Wide-field contact fundus photograph of an infant · Phoenix ICON, 100° FOV · 1240x1240
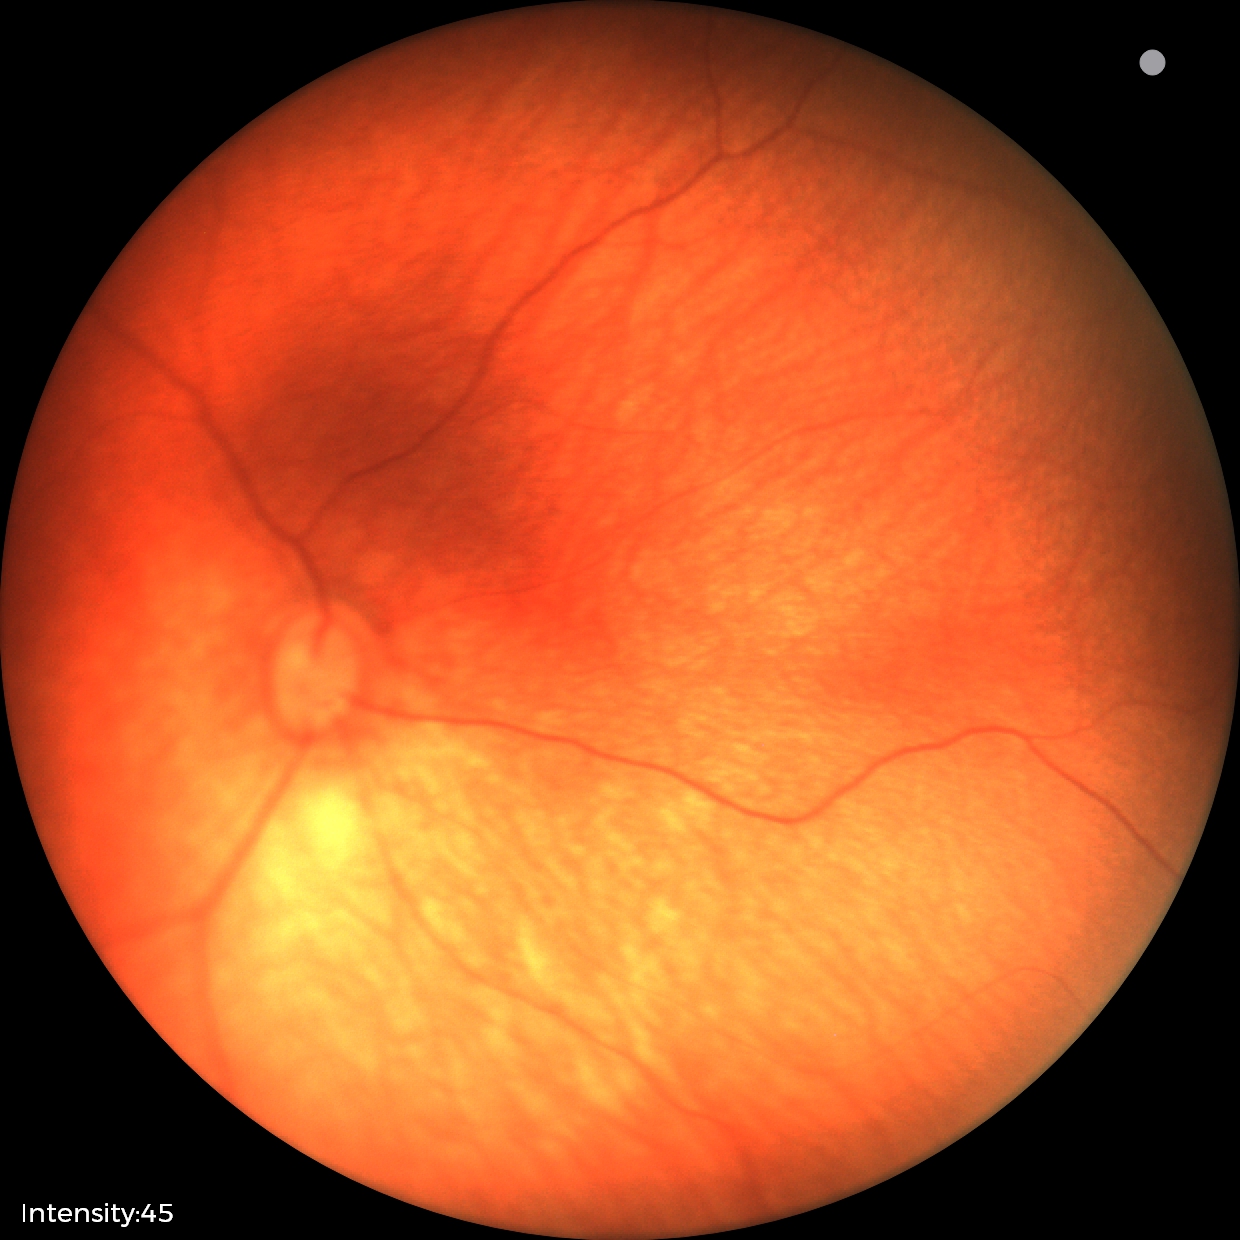
Assessment = normal retinal appearance.